Acquired on the Clarity RetCam 3 · wide-field contact fundus photograph of an infant — 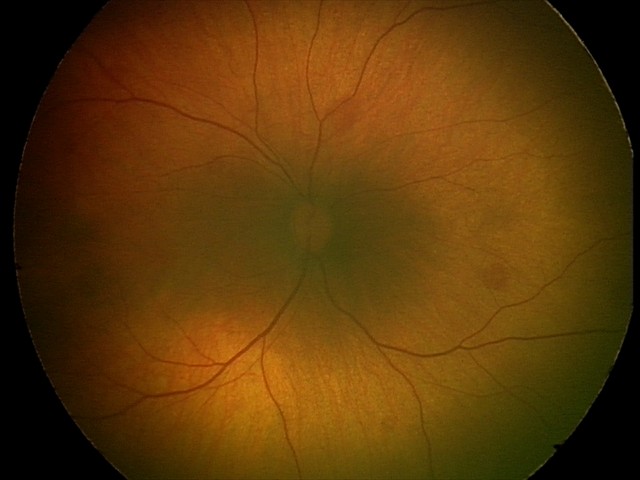 Series diagnosed as retinal hemorrhages.